Nidek AFC-330, non-mydriatic acquisition
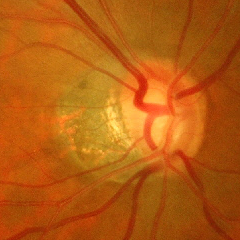 Assessment = advanced-stage glaucoma.